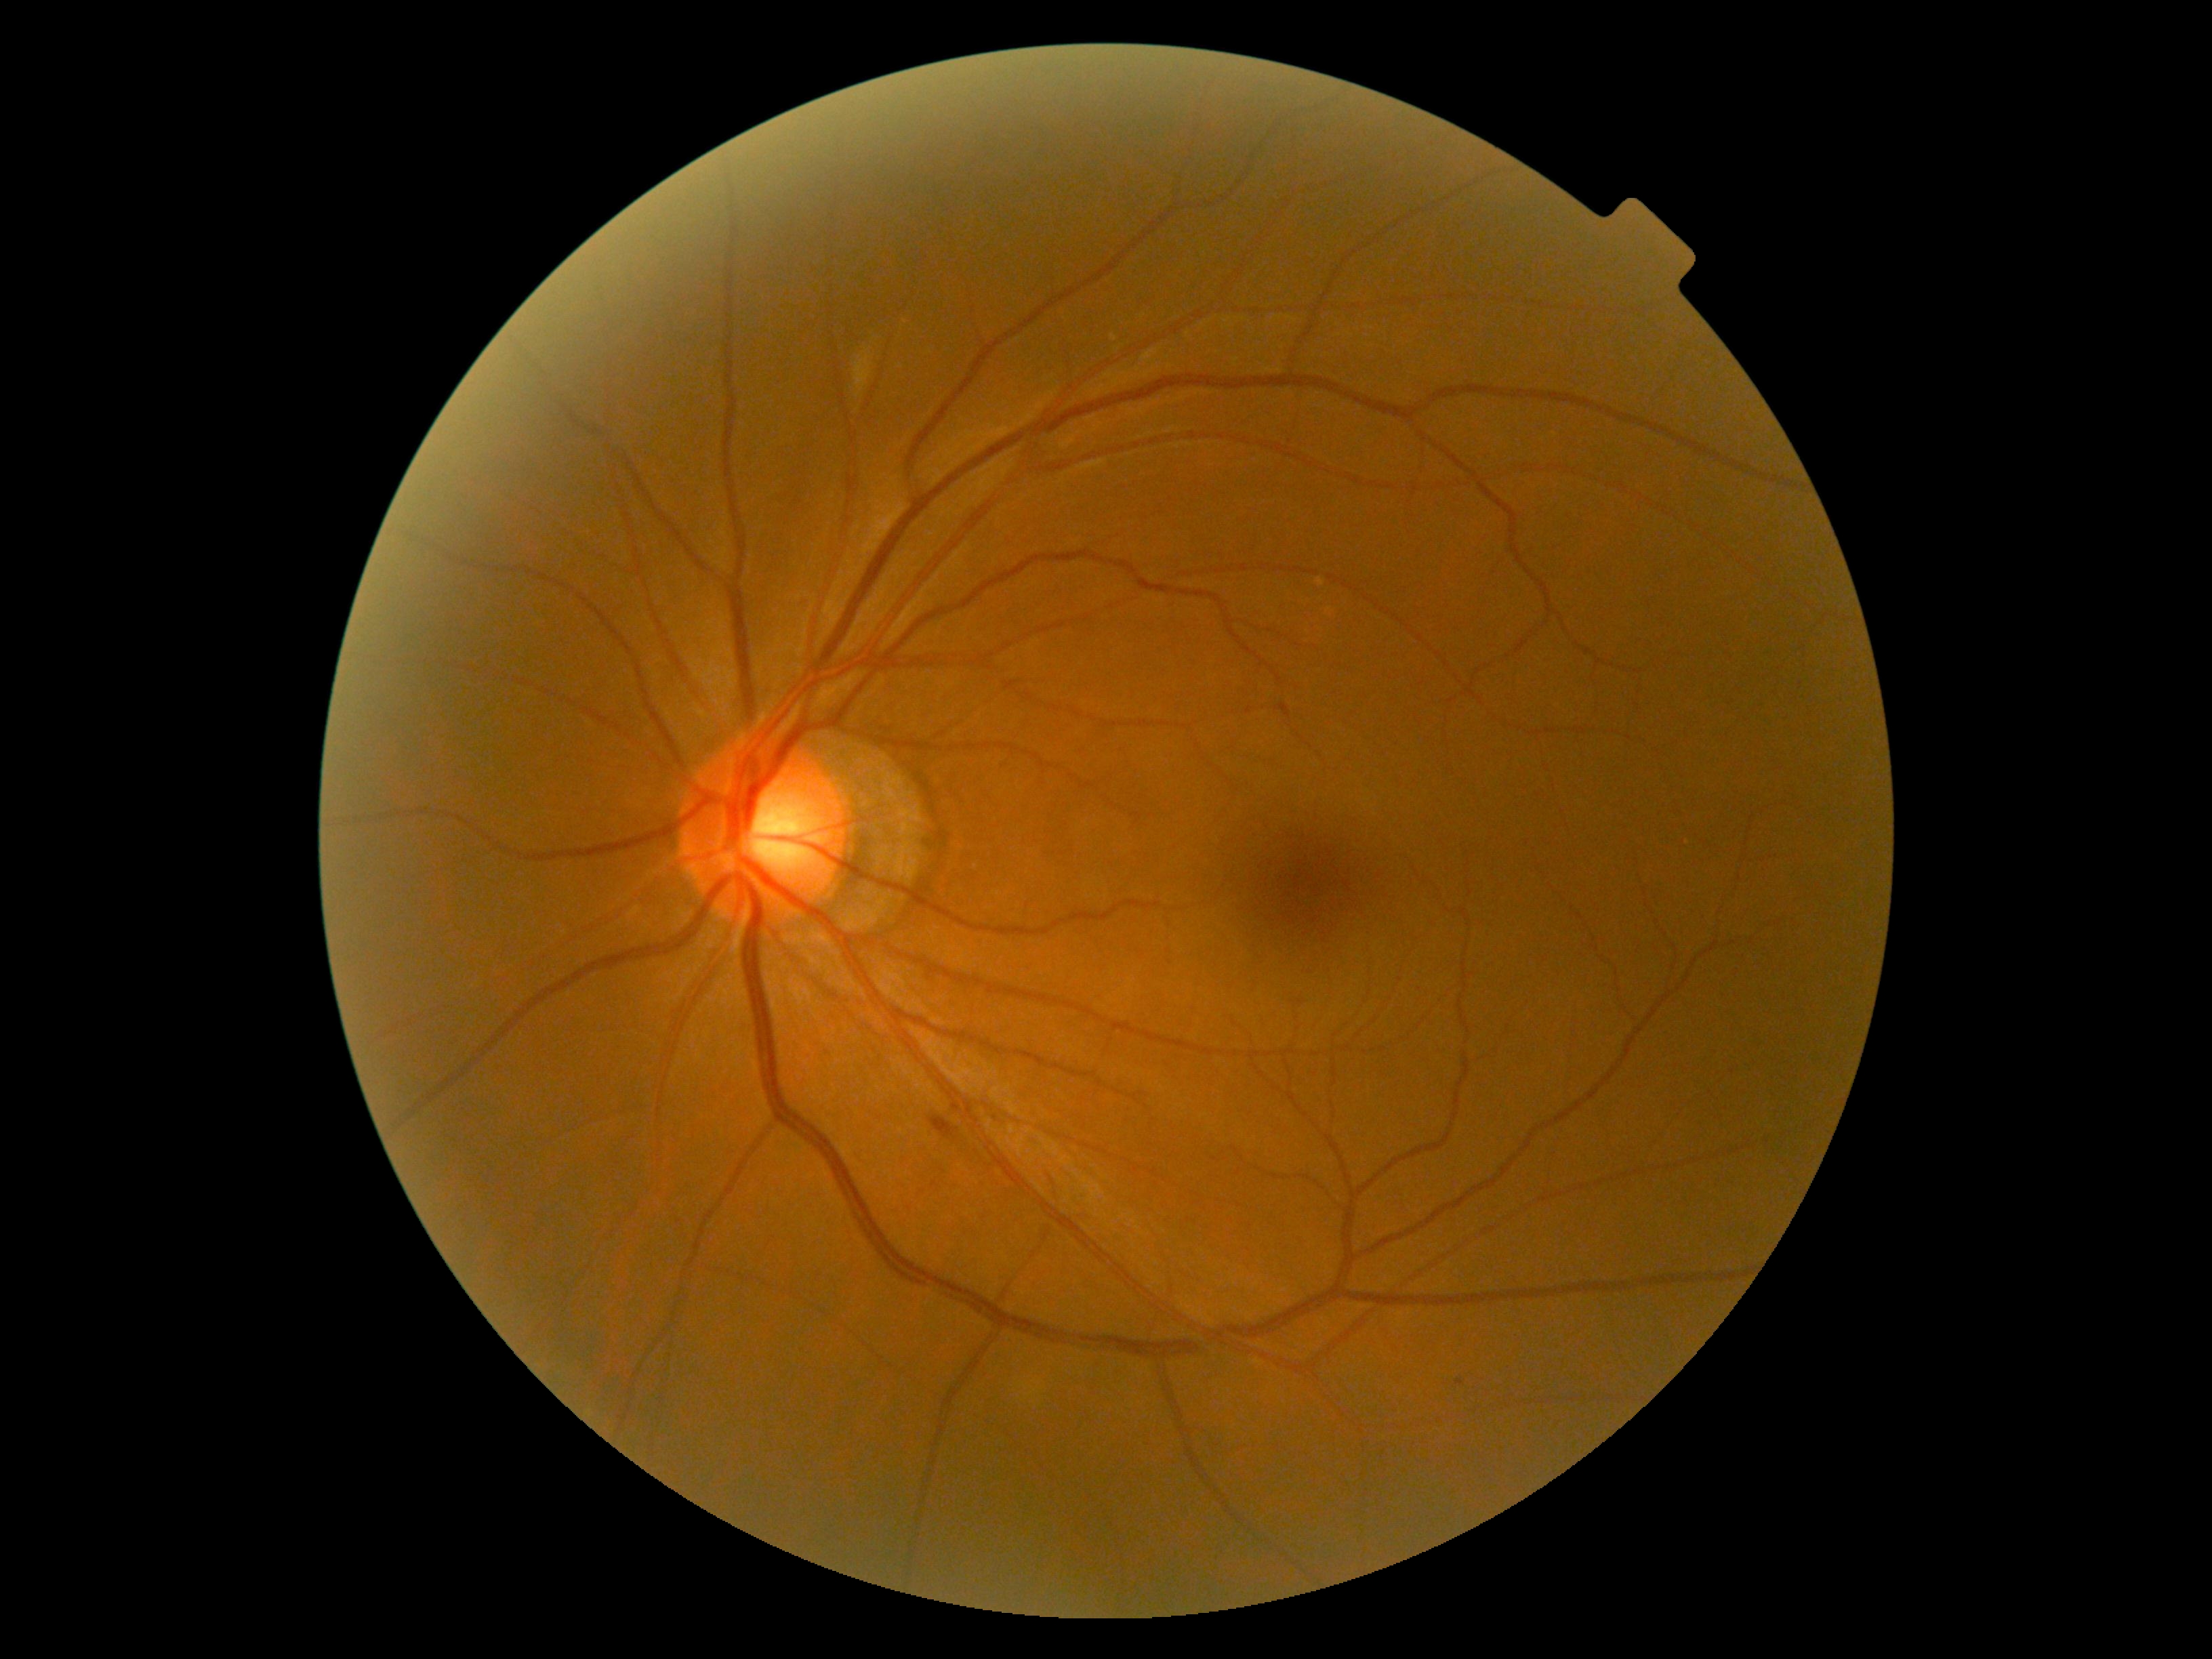

DR class = non-proliferative diabetic retinopathy; DR stage = moderate NPDR (grade 2) — more than just microaneurysms but less than severe NPDR.